No pharmacologic dilation — 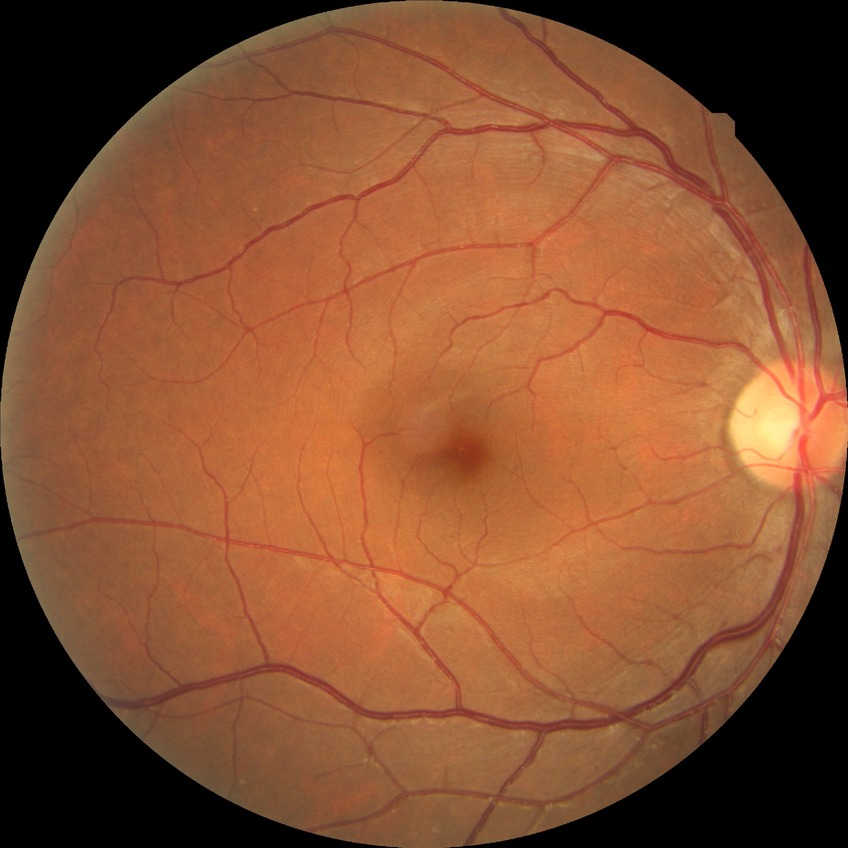
Findings:
* Davis grading — no diabetic retinopathy